1380x1382 — 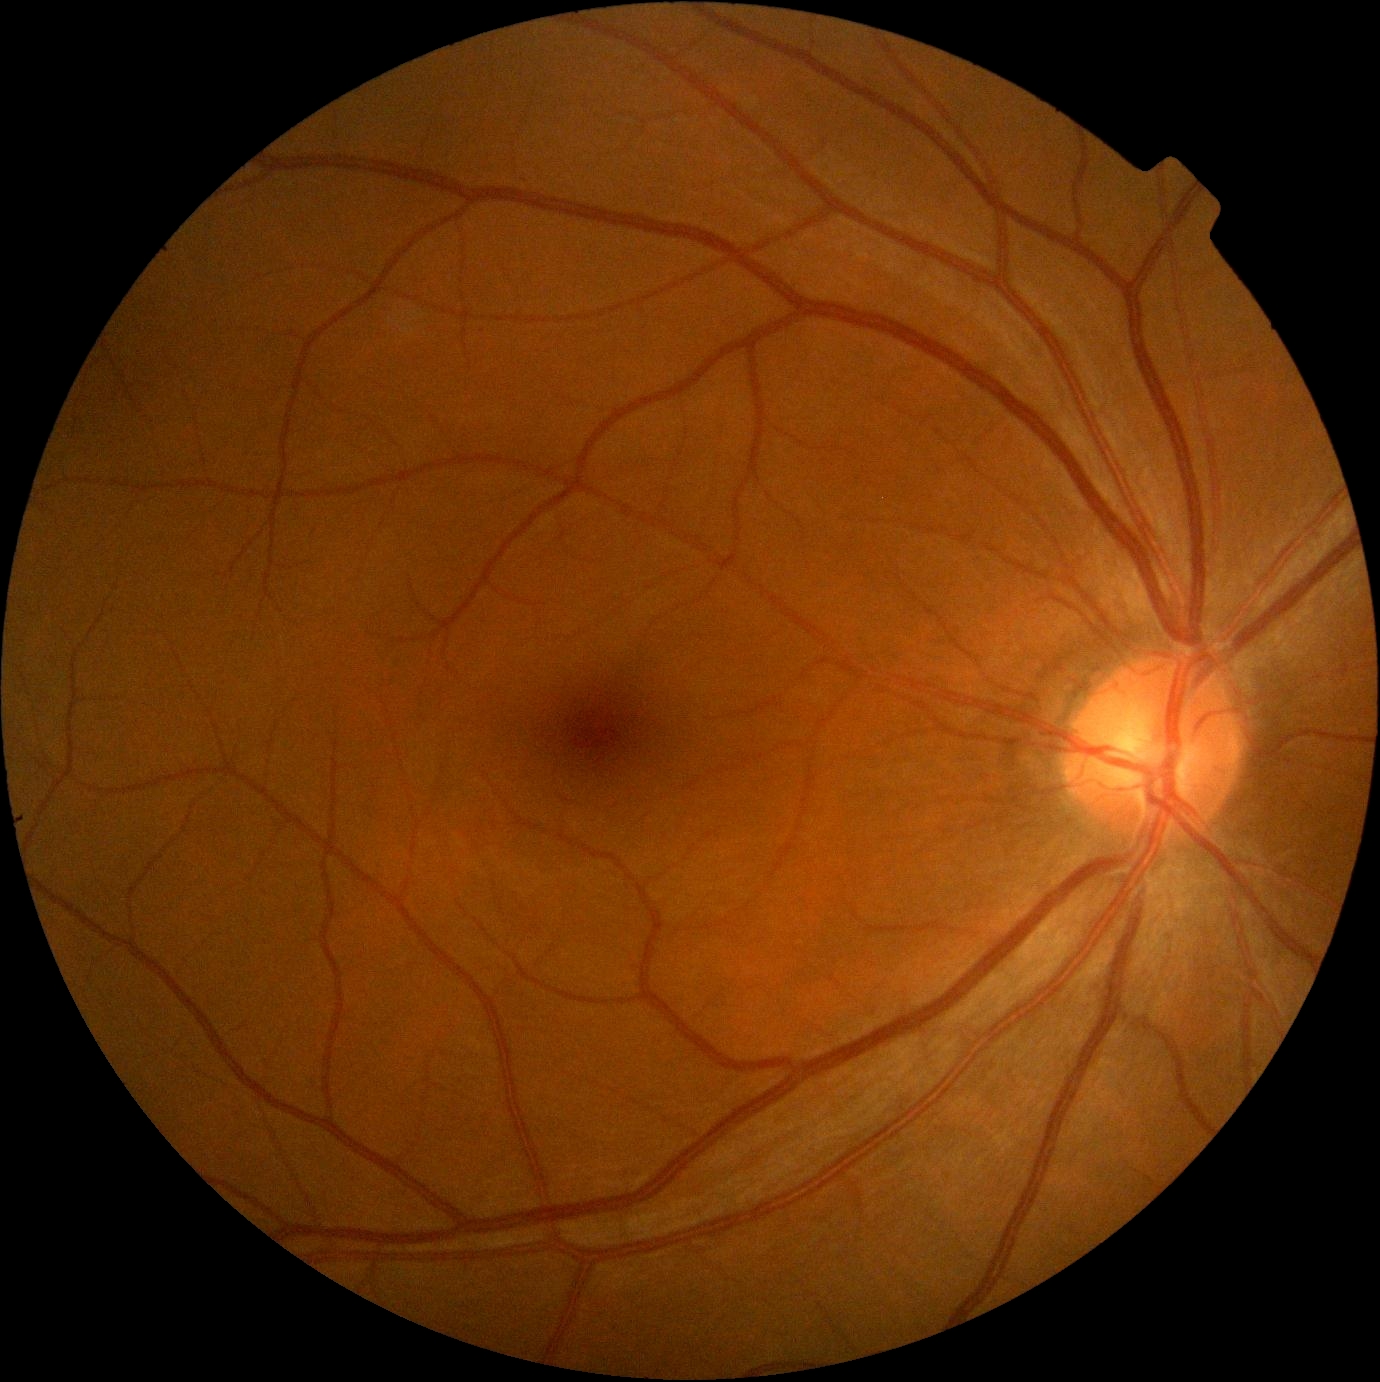

Retinopathy is grade 0.